DR severity per modified Davis staging; color fundus photograph; 848 by 848 pixels; no pharmacologic dilation — 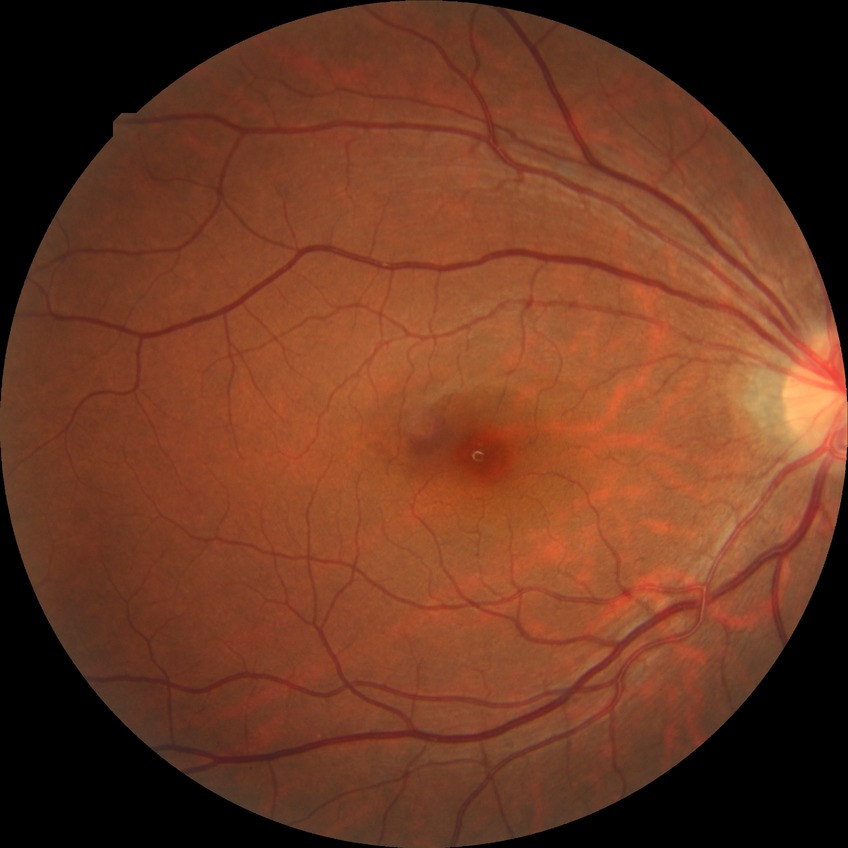 diabetic retinopathy (DR): NDR (no diabetic retinopathy)